1240 x 1240 pixels. Wide-field contact fundus photograph of an infant. Captured with the Phoenix ICON (100° field of view):
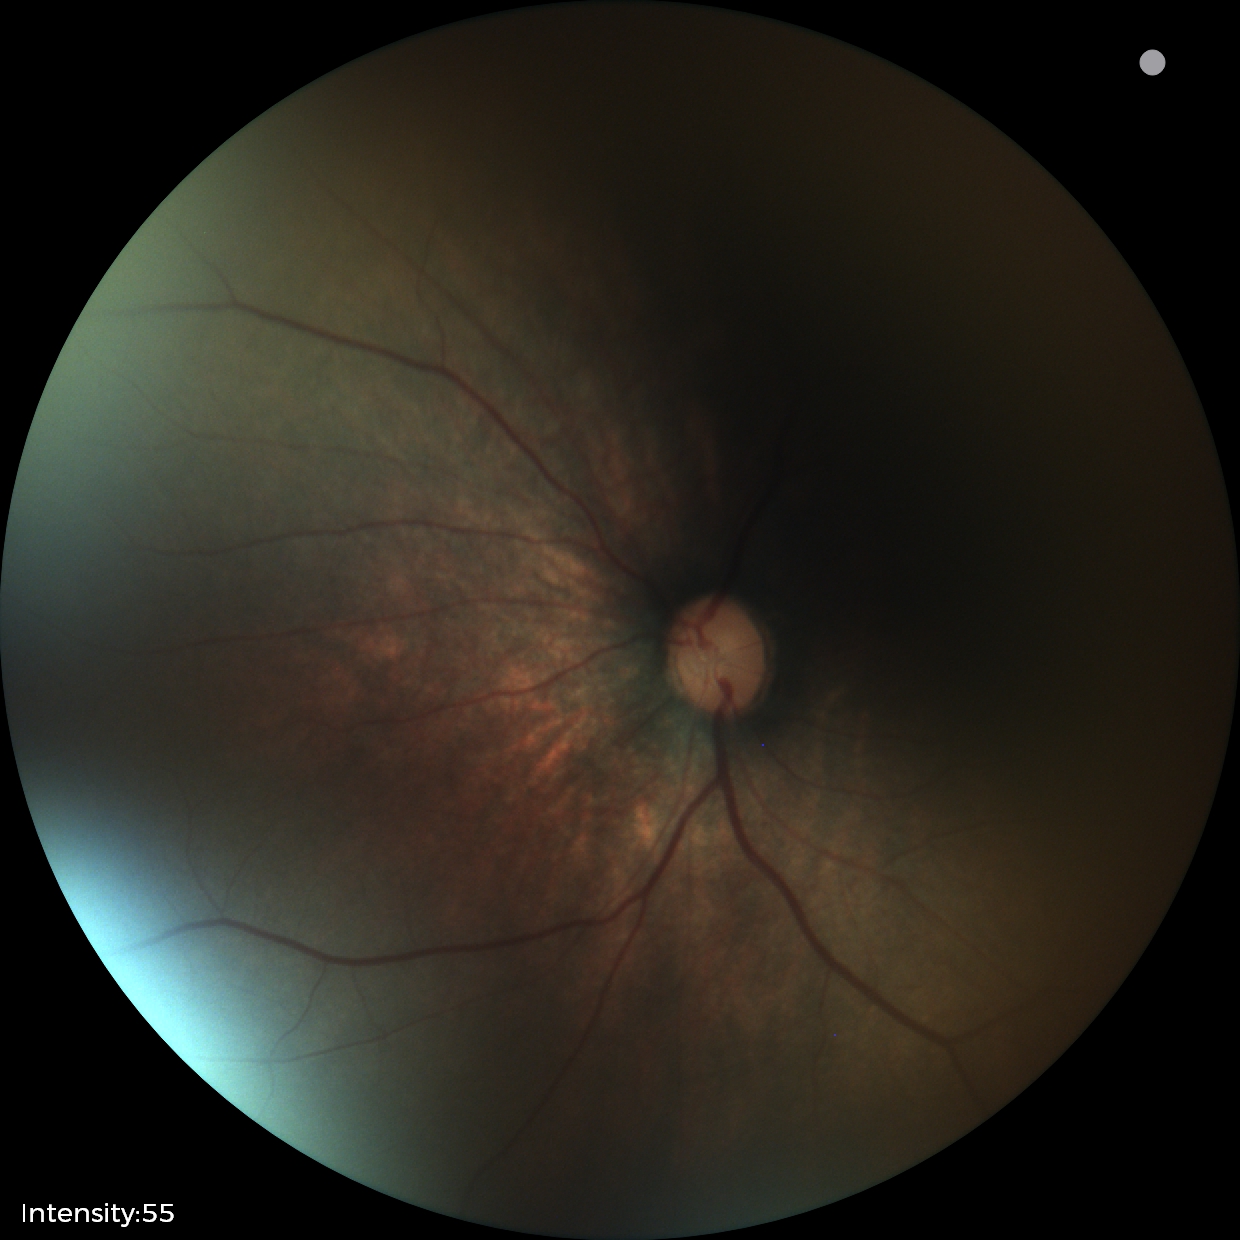

Screening examination with no abnormal retinal findings.